Modified Davis classification. Nonmydriatic fundus photograph. 45° field of view: 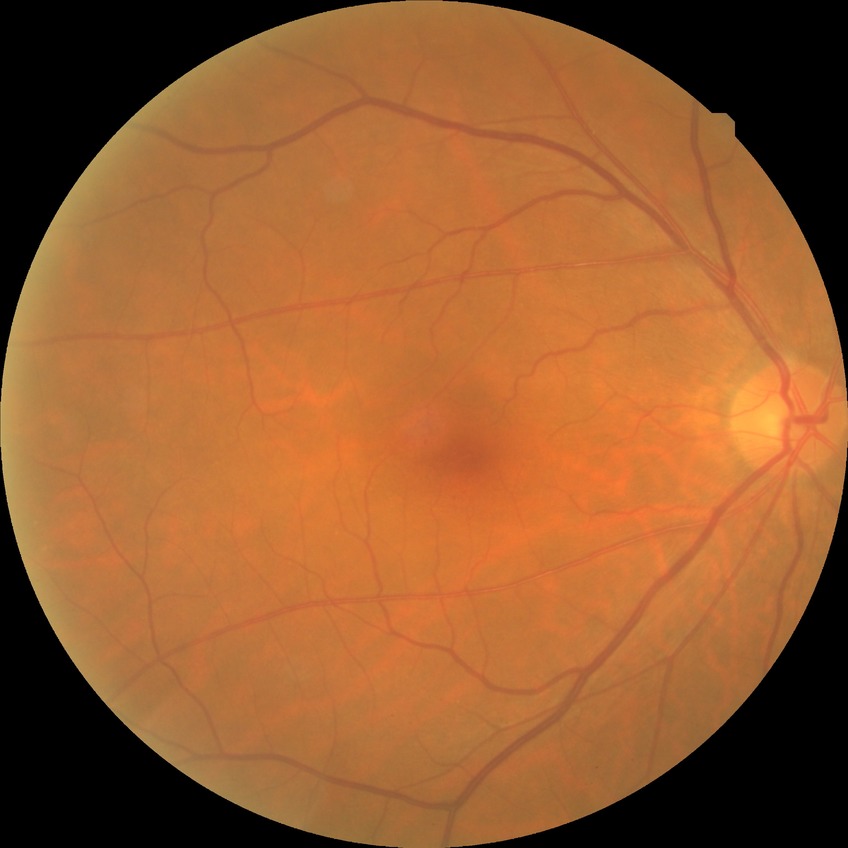 DR severity: SDR.
The retinopathy is classified as non-proliferative diabetic retinopathy.